45-degree field of view. 848 x 848 pixels. Posterior pole photograph. Nonmydriatic fundus photograph
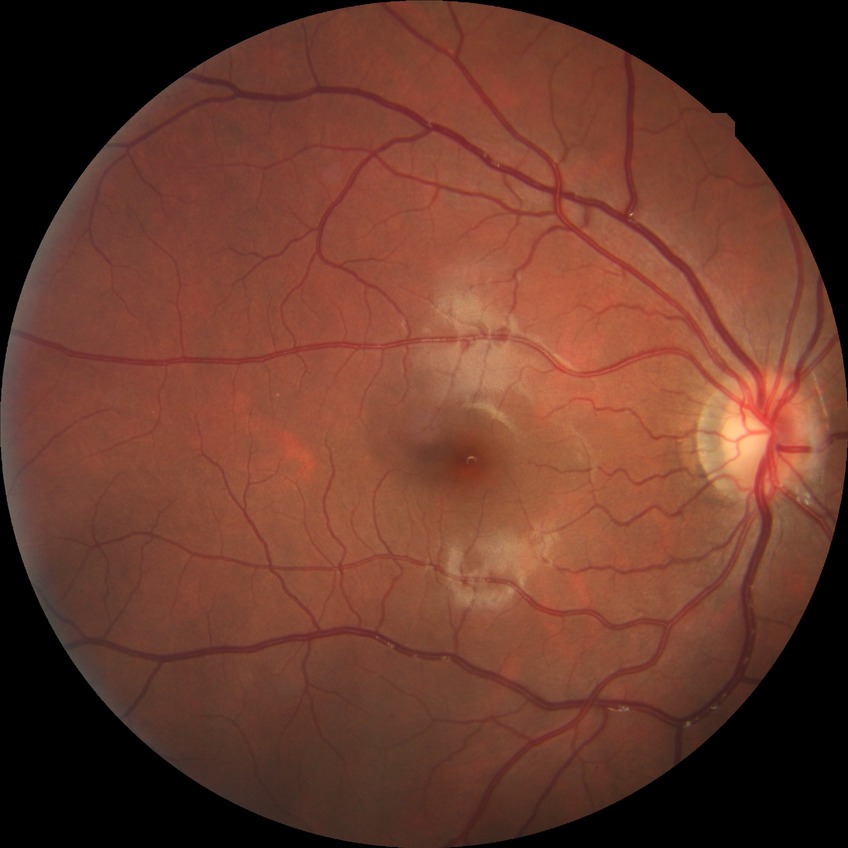 Retinopathy grade is no diabetic retinopathy.